412 by 310 pixels. Retinal fundus photograph
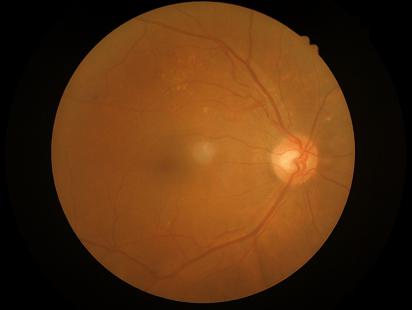

  contrast: good
  clarity: in focus
  overall_quality: good